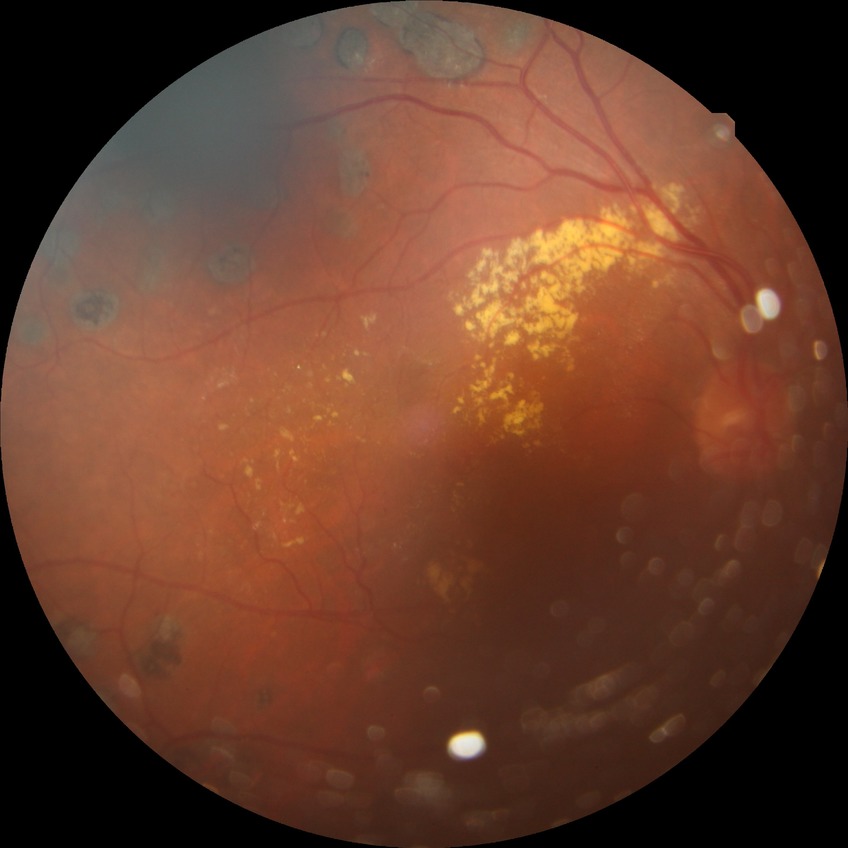

Diabetic retinopathy (DR) is proliferative diabetic retinopathy (PDR).